2346x1568px
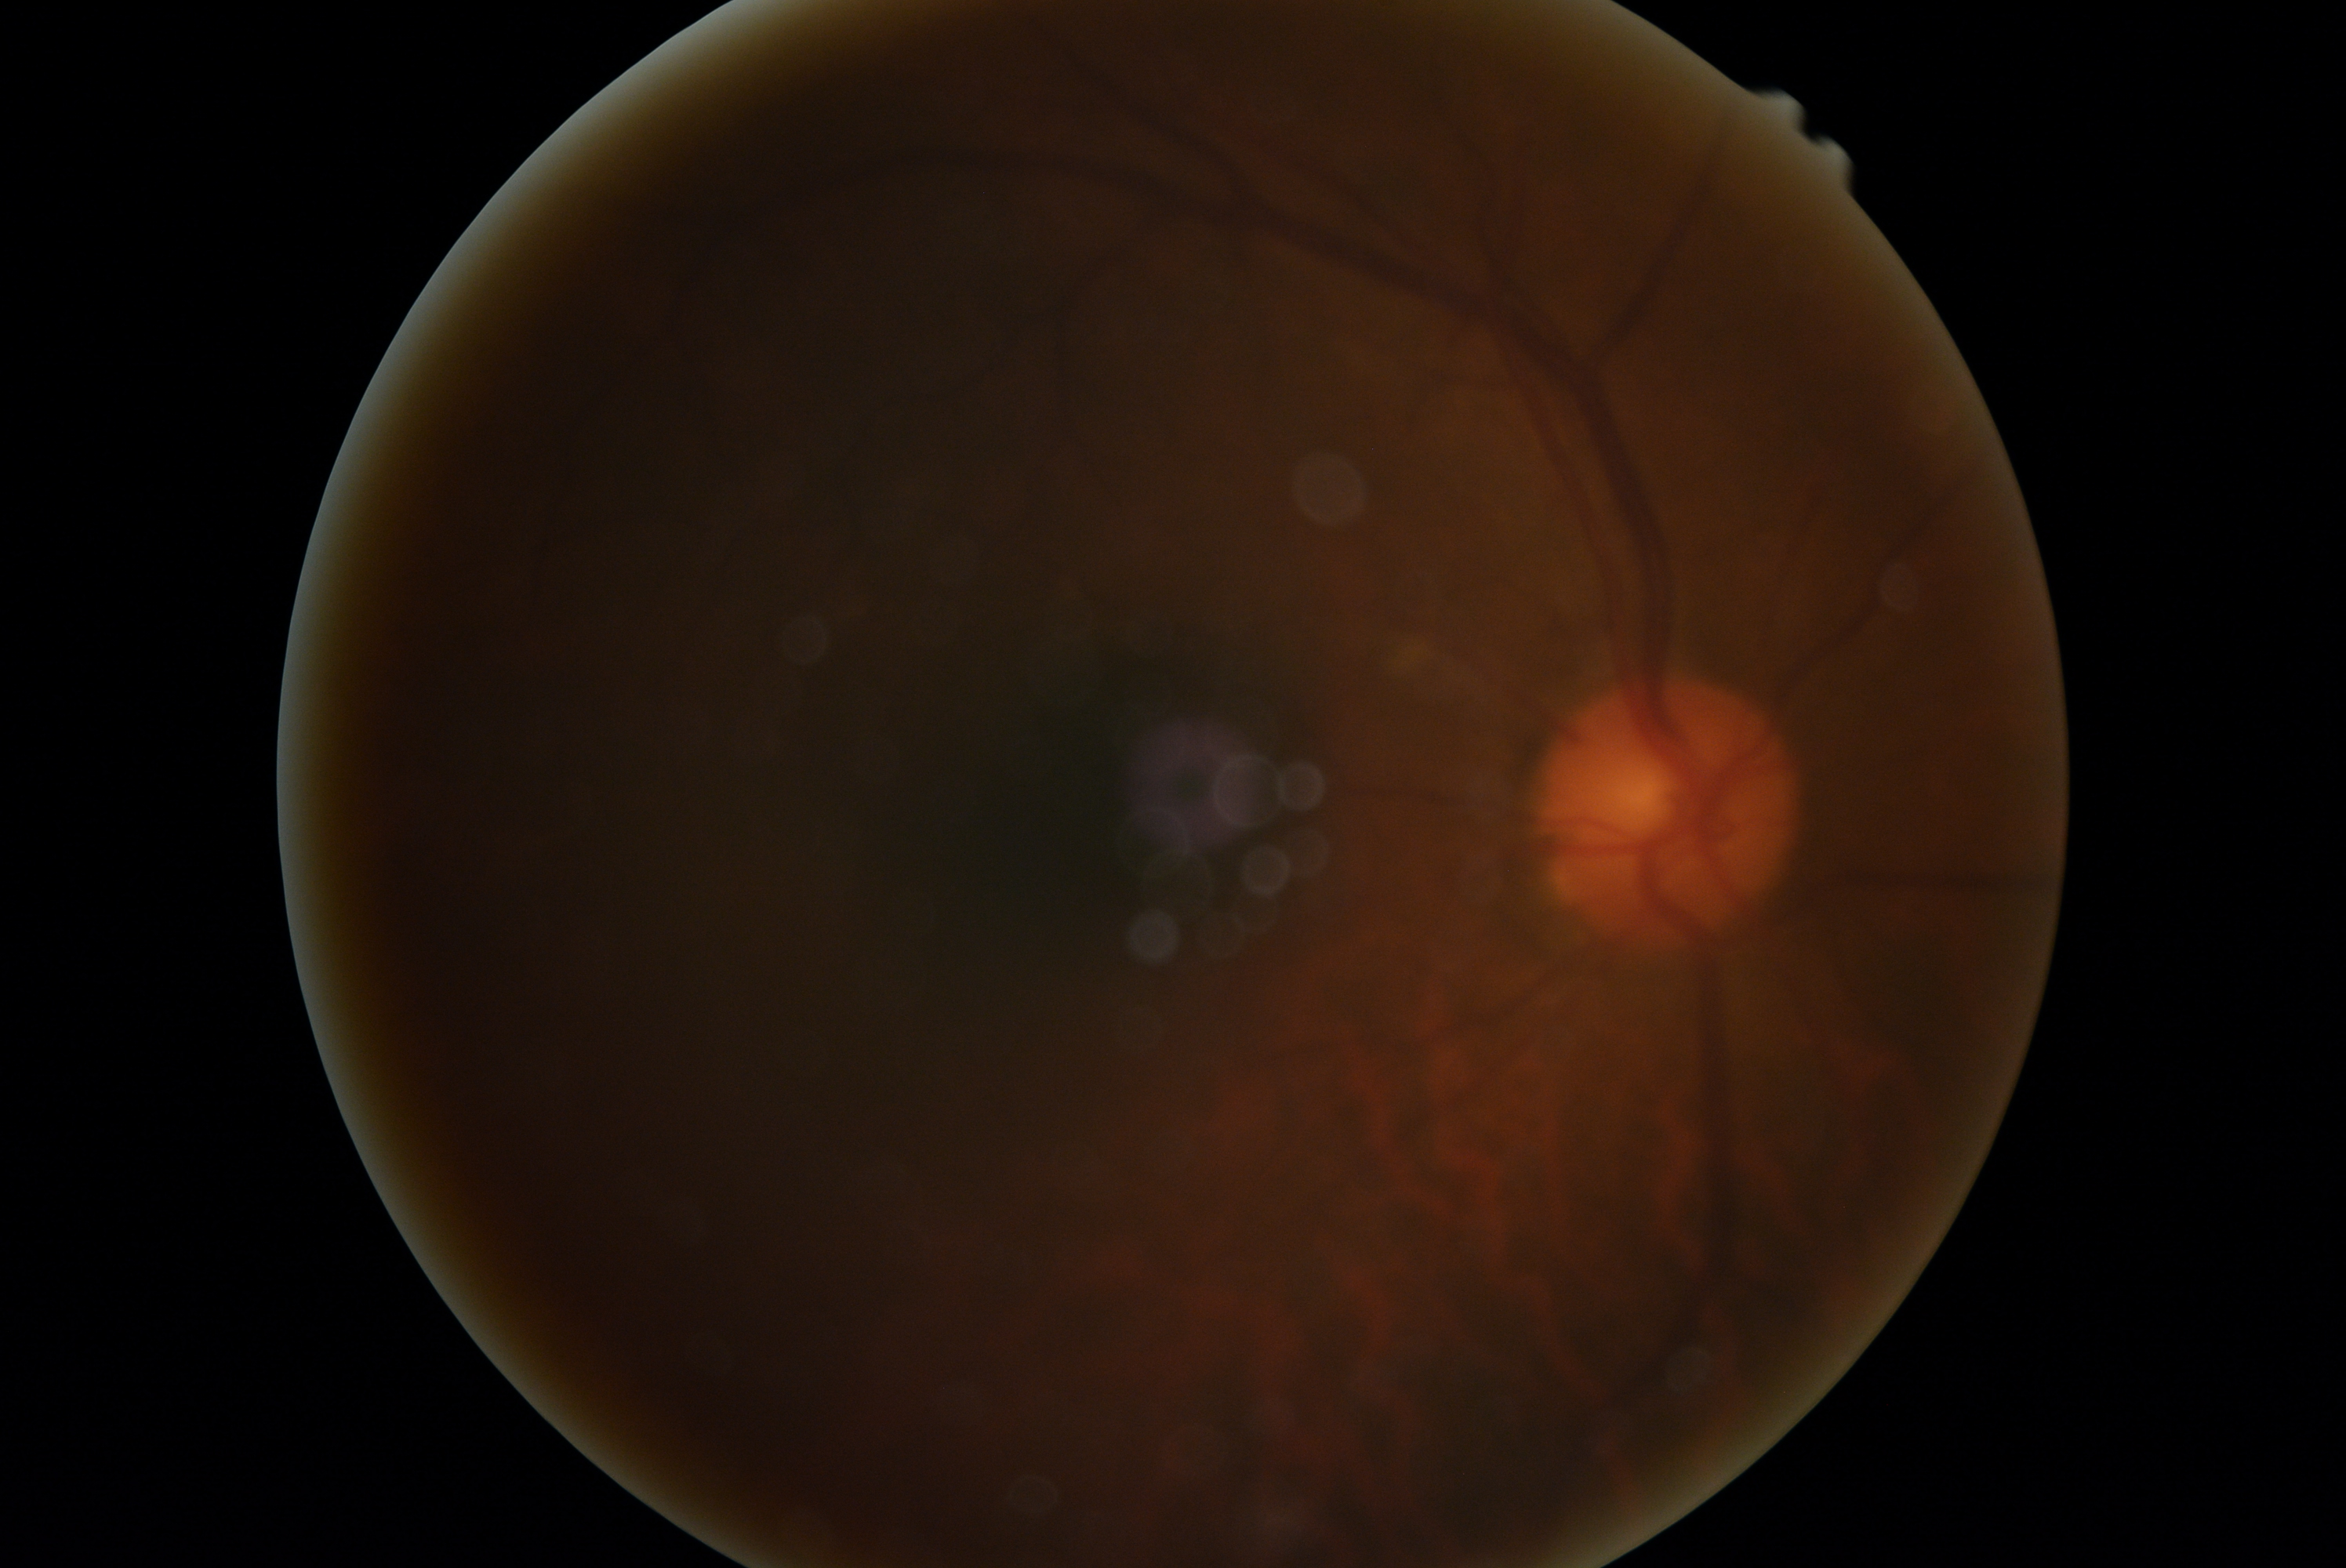
DR severity is no apparent retinopathy (grade 0).